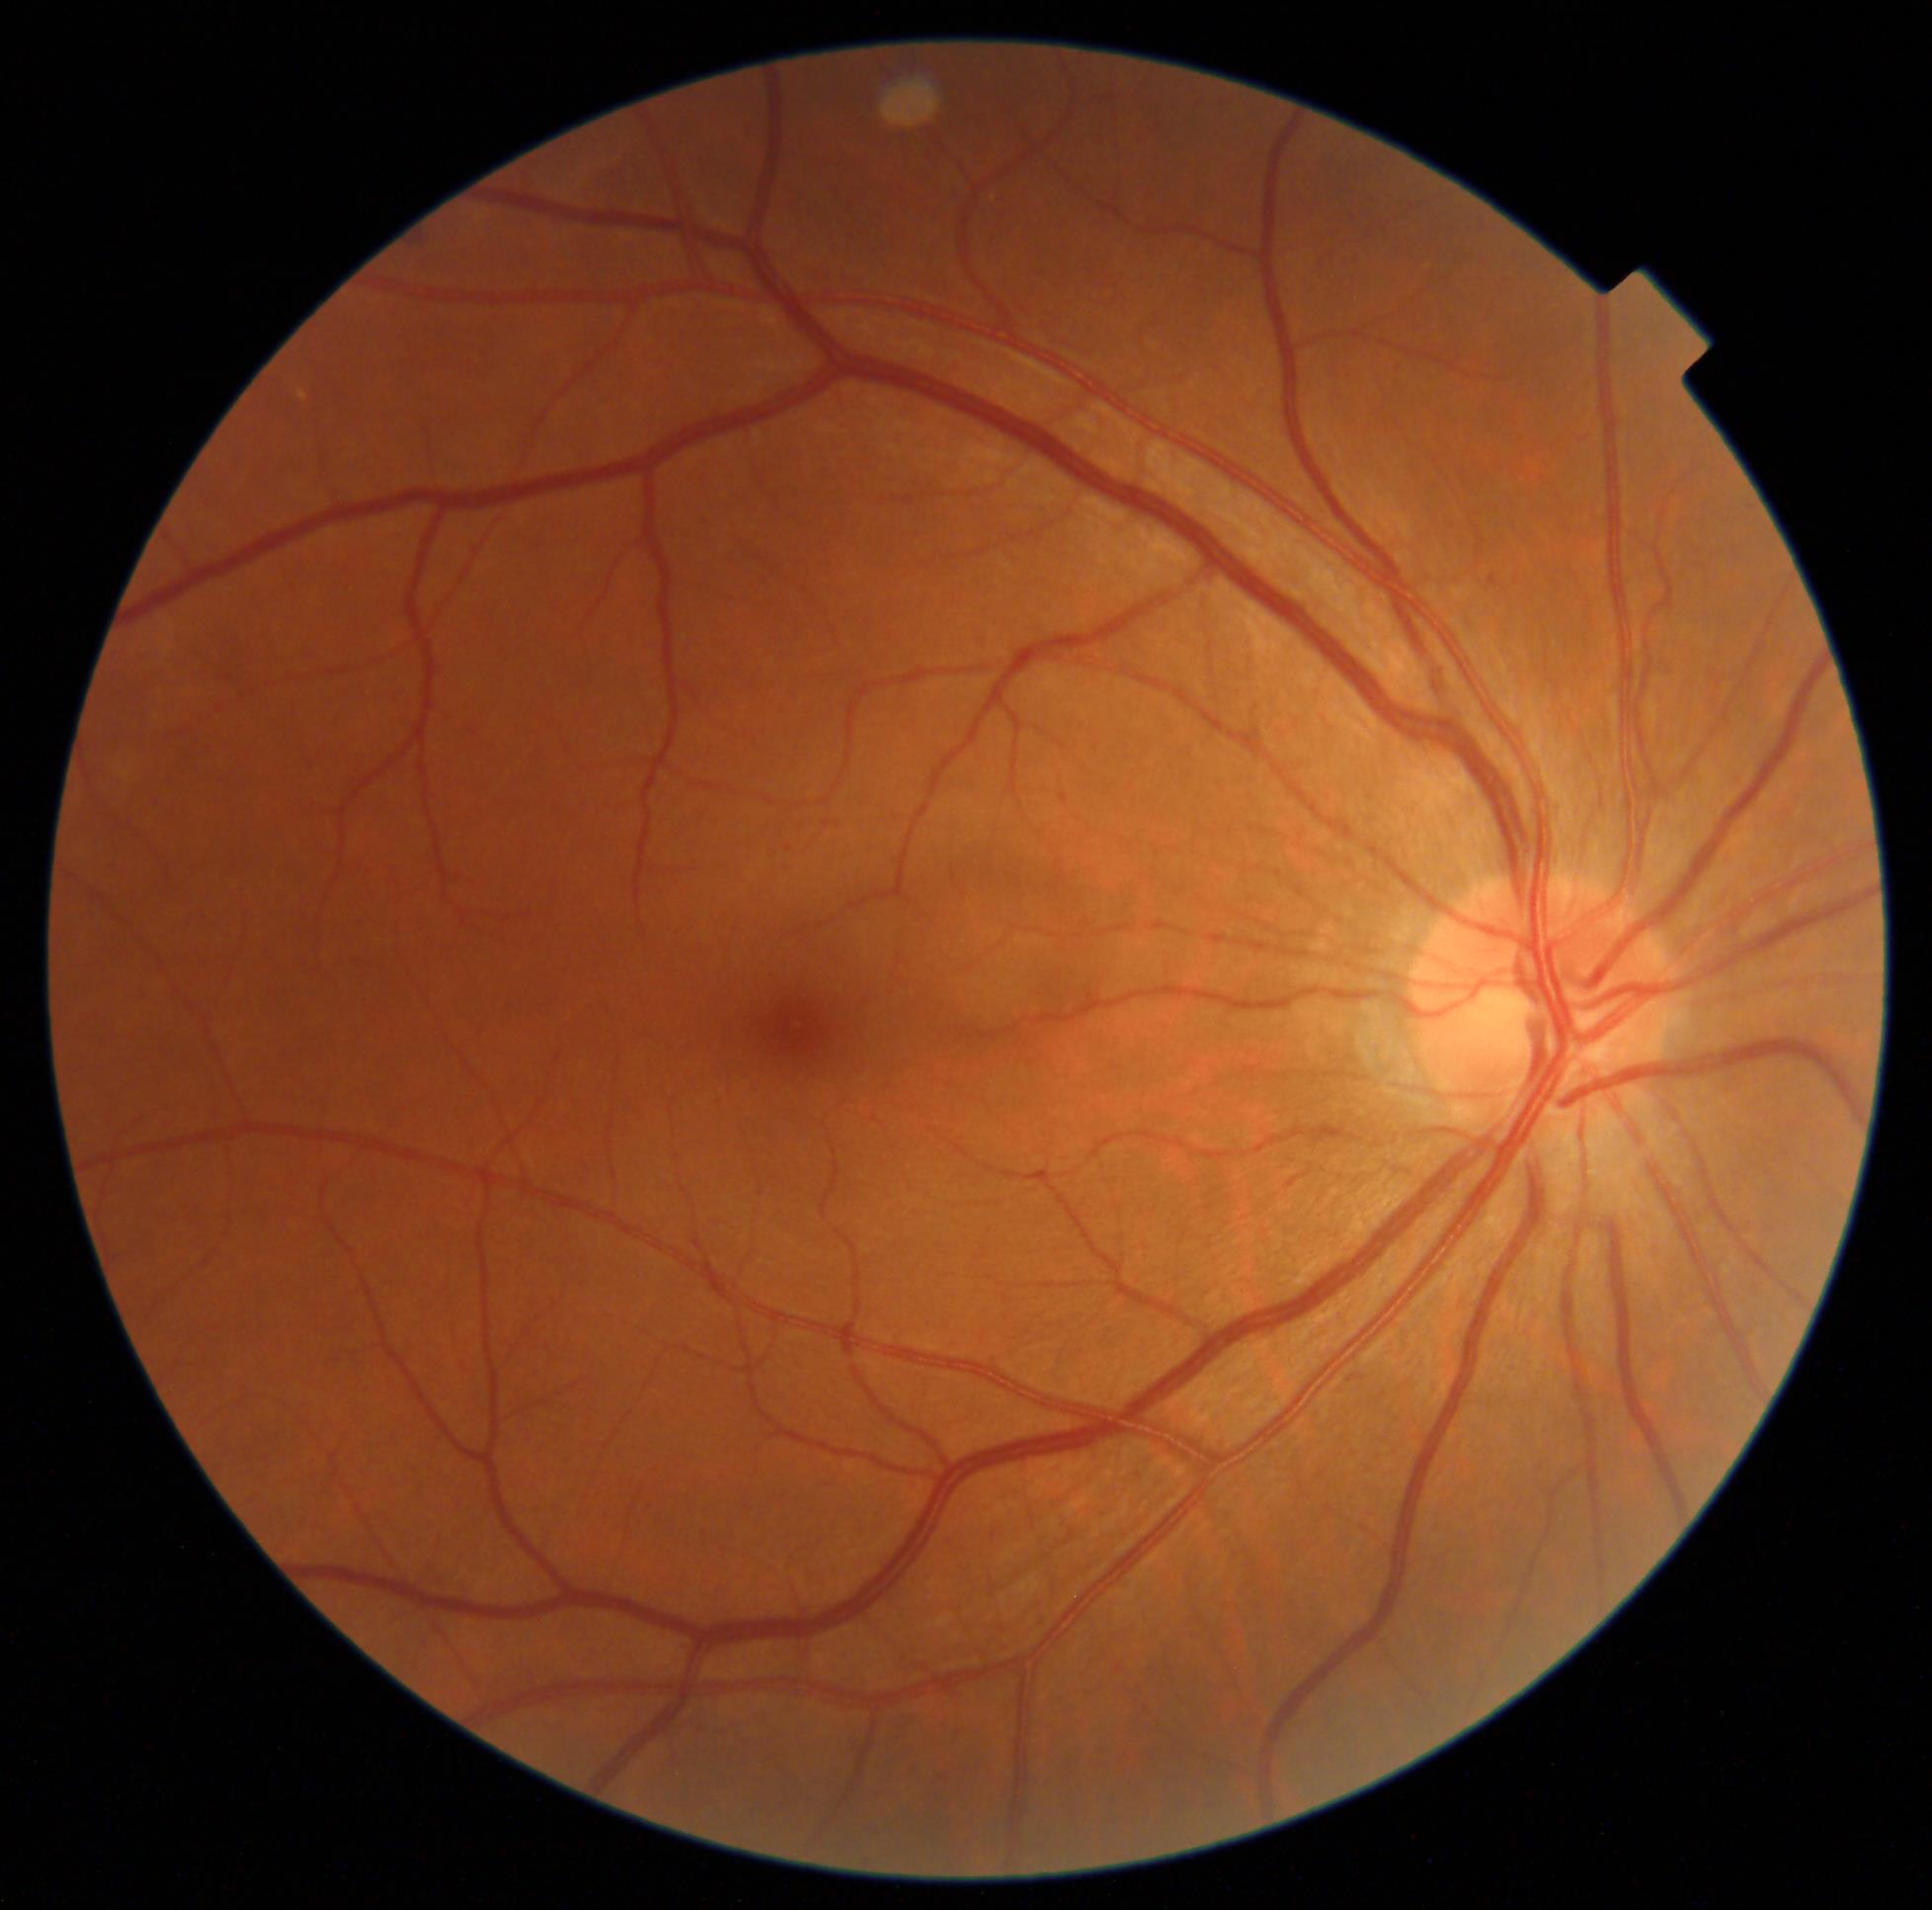

DR severity: mild NPDR (grade 1).